1932 by 1932 pixels: 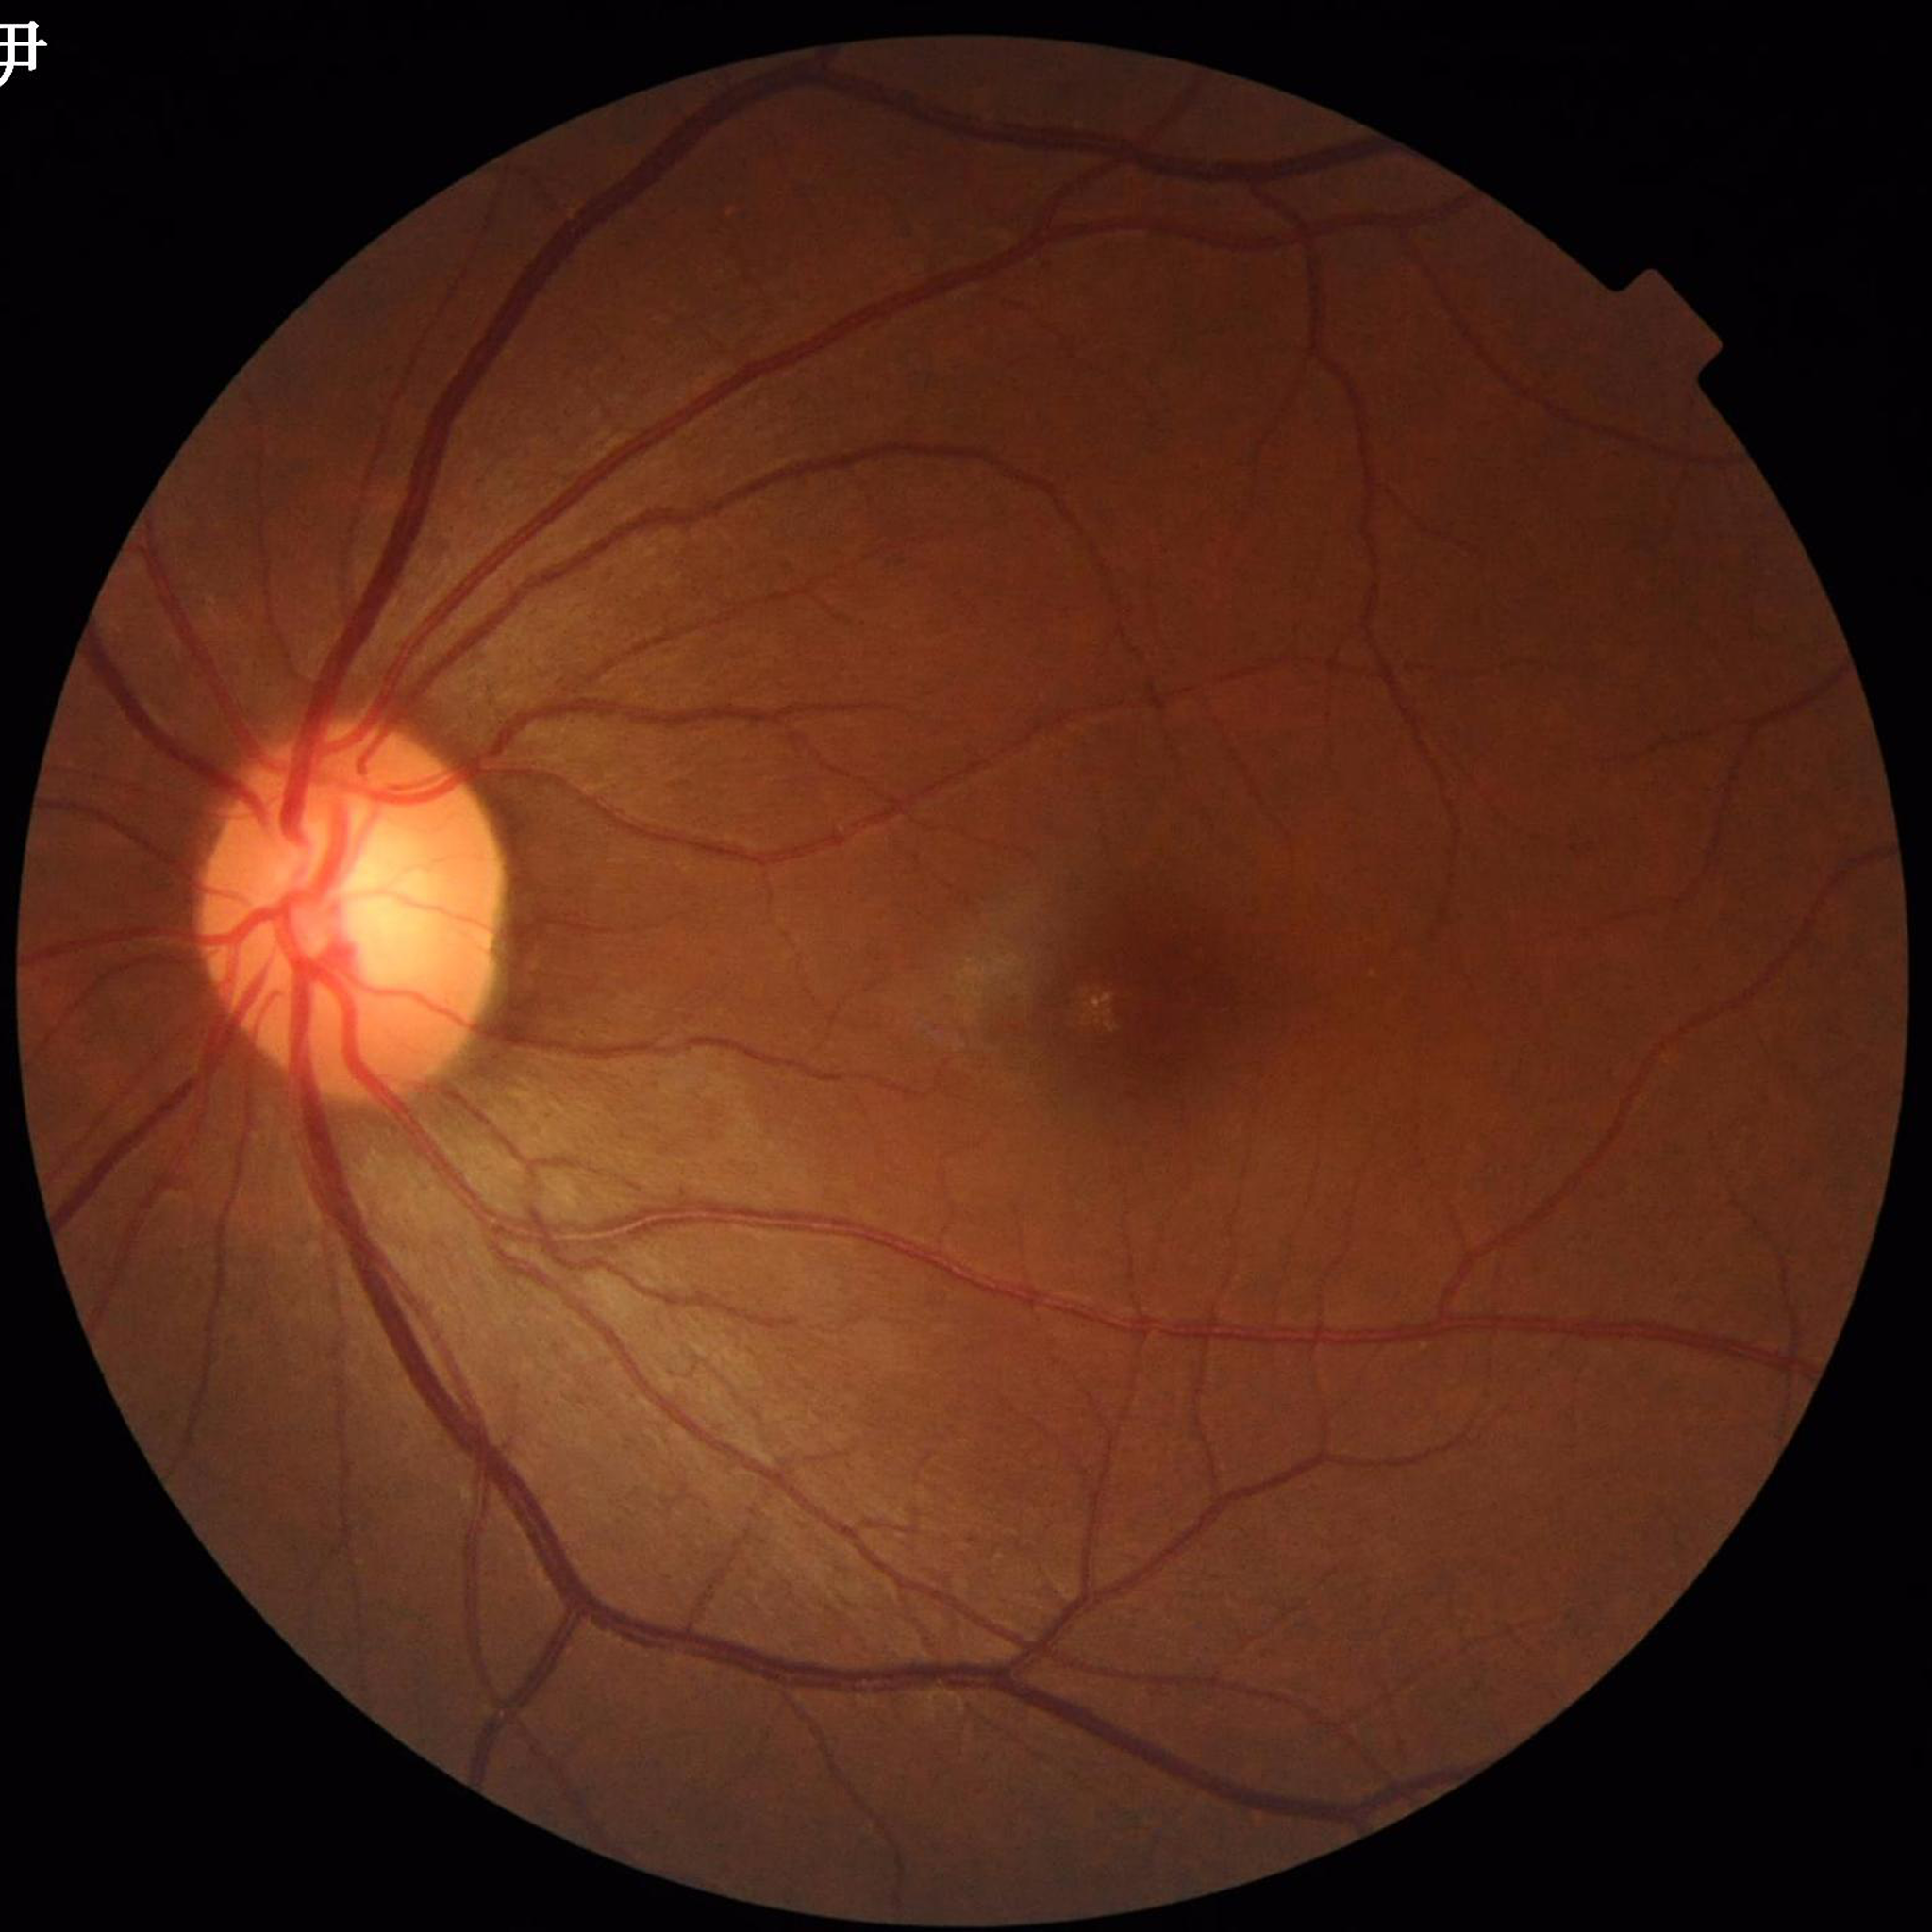
This fundus photograph is from a patient diagnosed with glaucoma.